Camera: NIDEK AFC-230
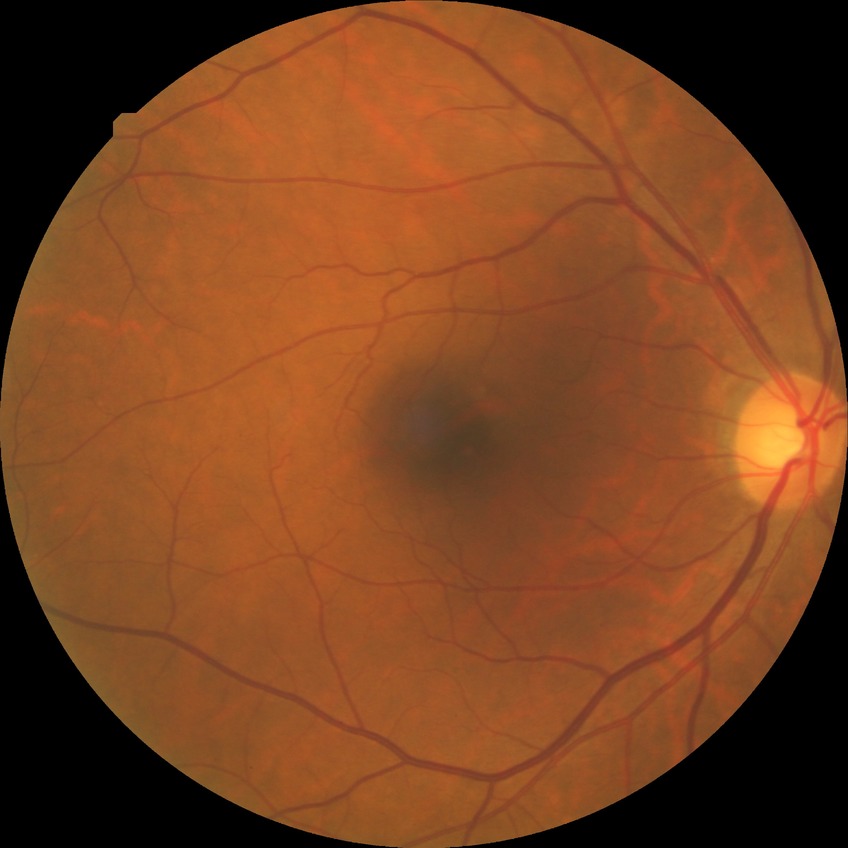
diabetic retinopathy (DR): no diabetic retinopathy (NDR).